Retinal fundus photograph; 1924 by 1556 pixels
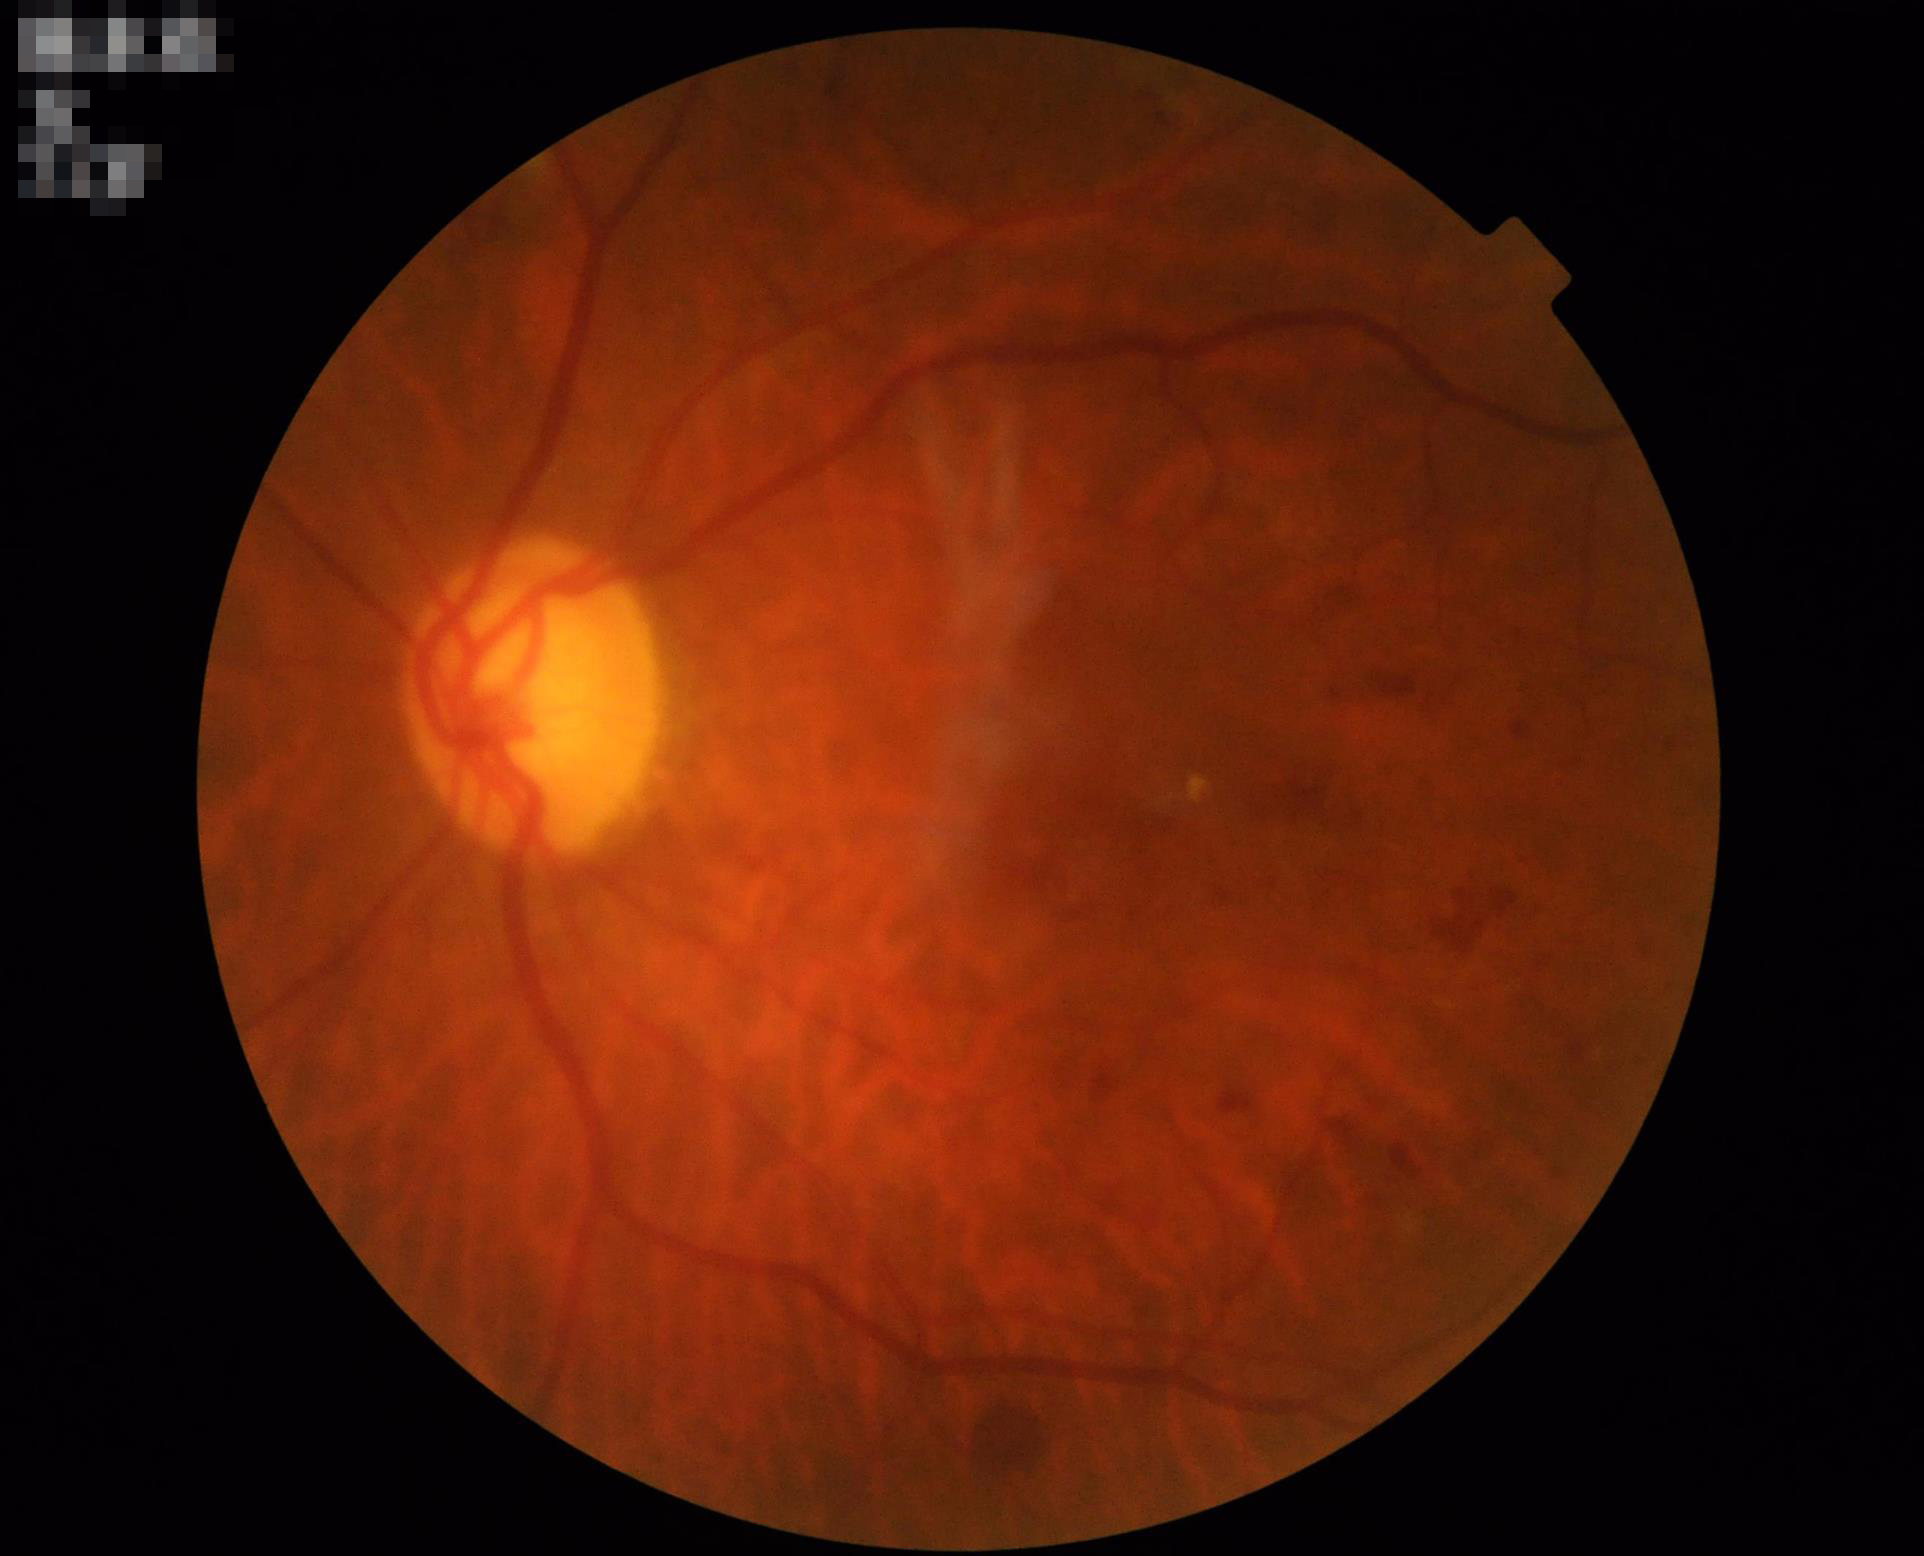

Contrast = adequate | Overall = satisfactory | Clarity = in focus | Illumination = satisfactory.